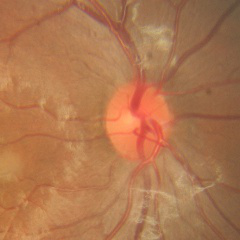
Findings consistent with no glaucomatous changes.